512x512
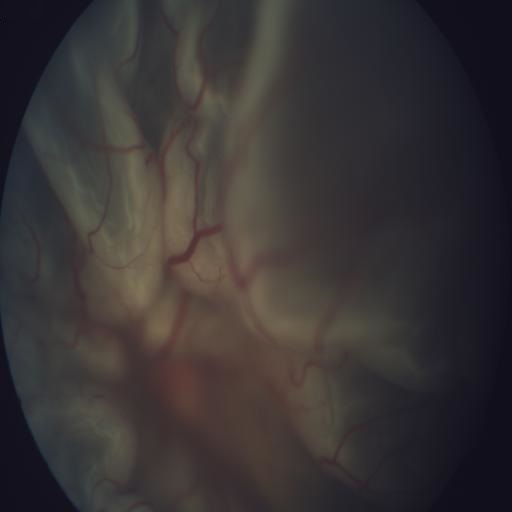 The image shows RD (retinal detachment).